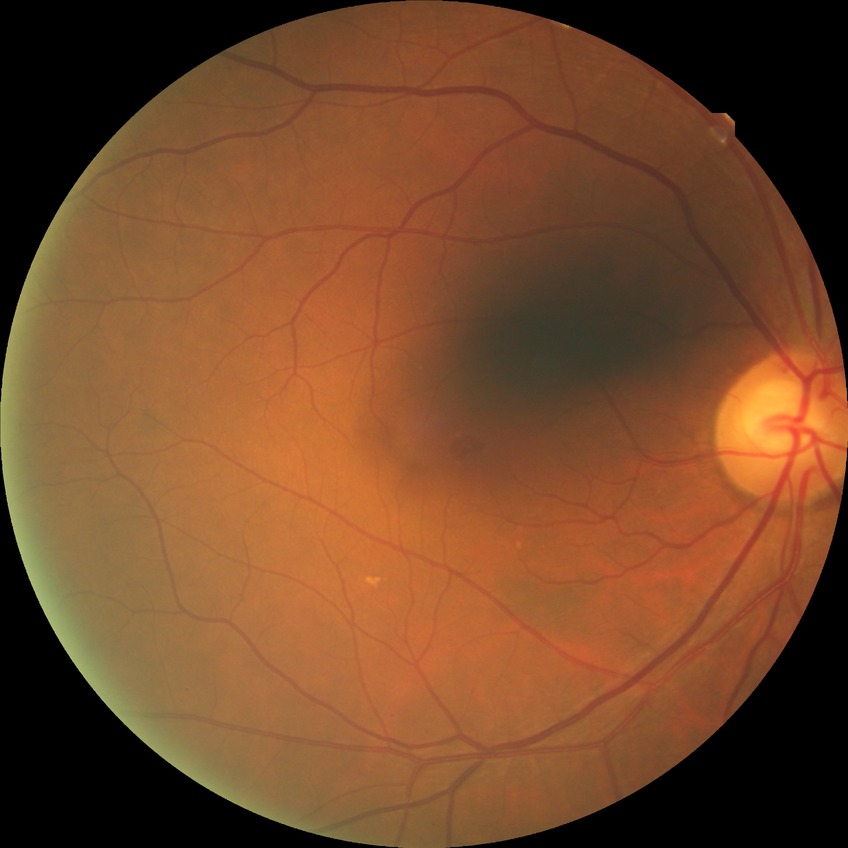 Davis stage is NDR.